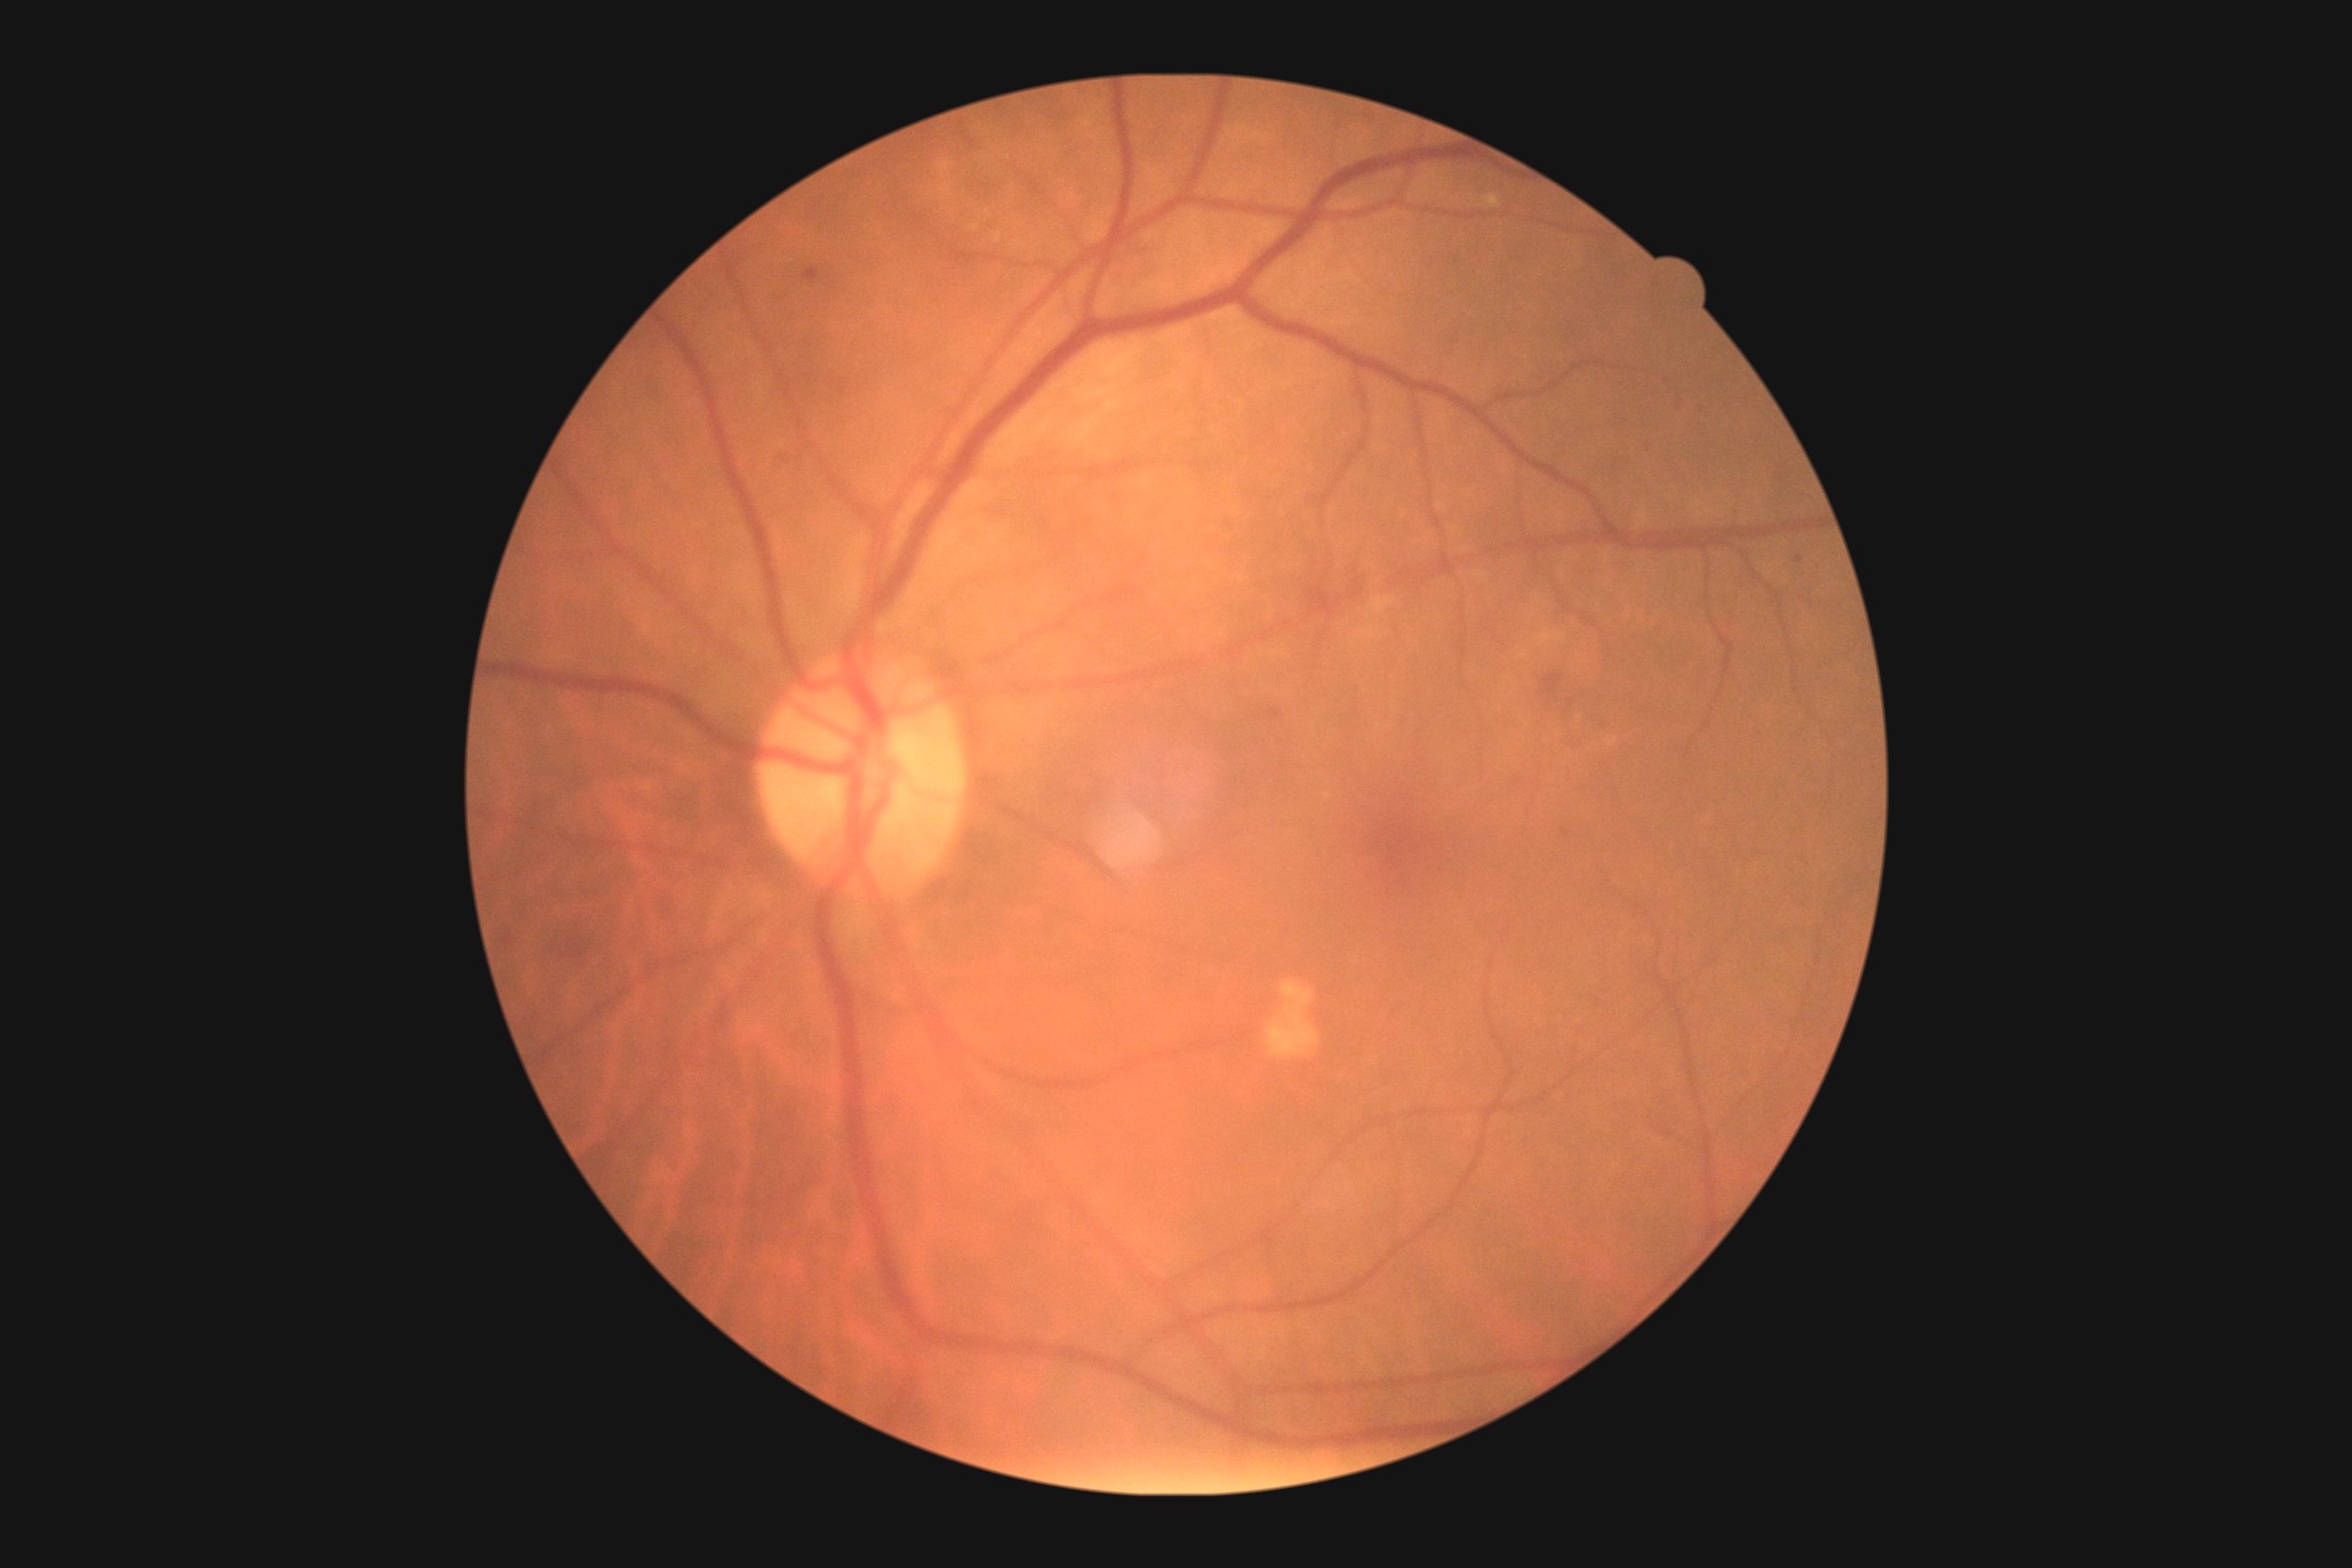 DR class = non-proliferative diabetic retinopathy, diabetic retinopathy grade = 2 (moderate NPDR) — more than just microaneurysms but less than severe NPDR.